Image size 2352x1568: 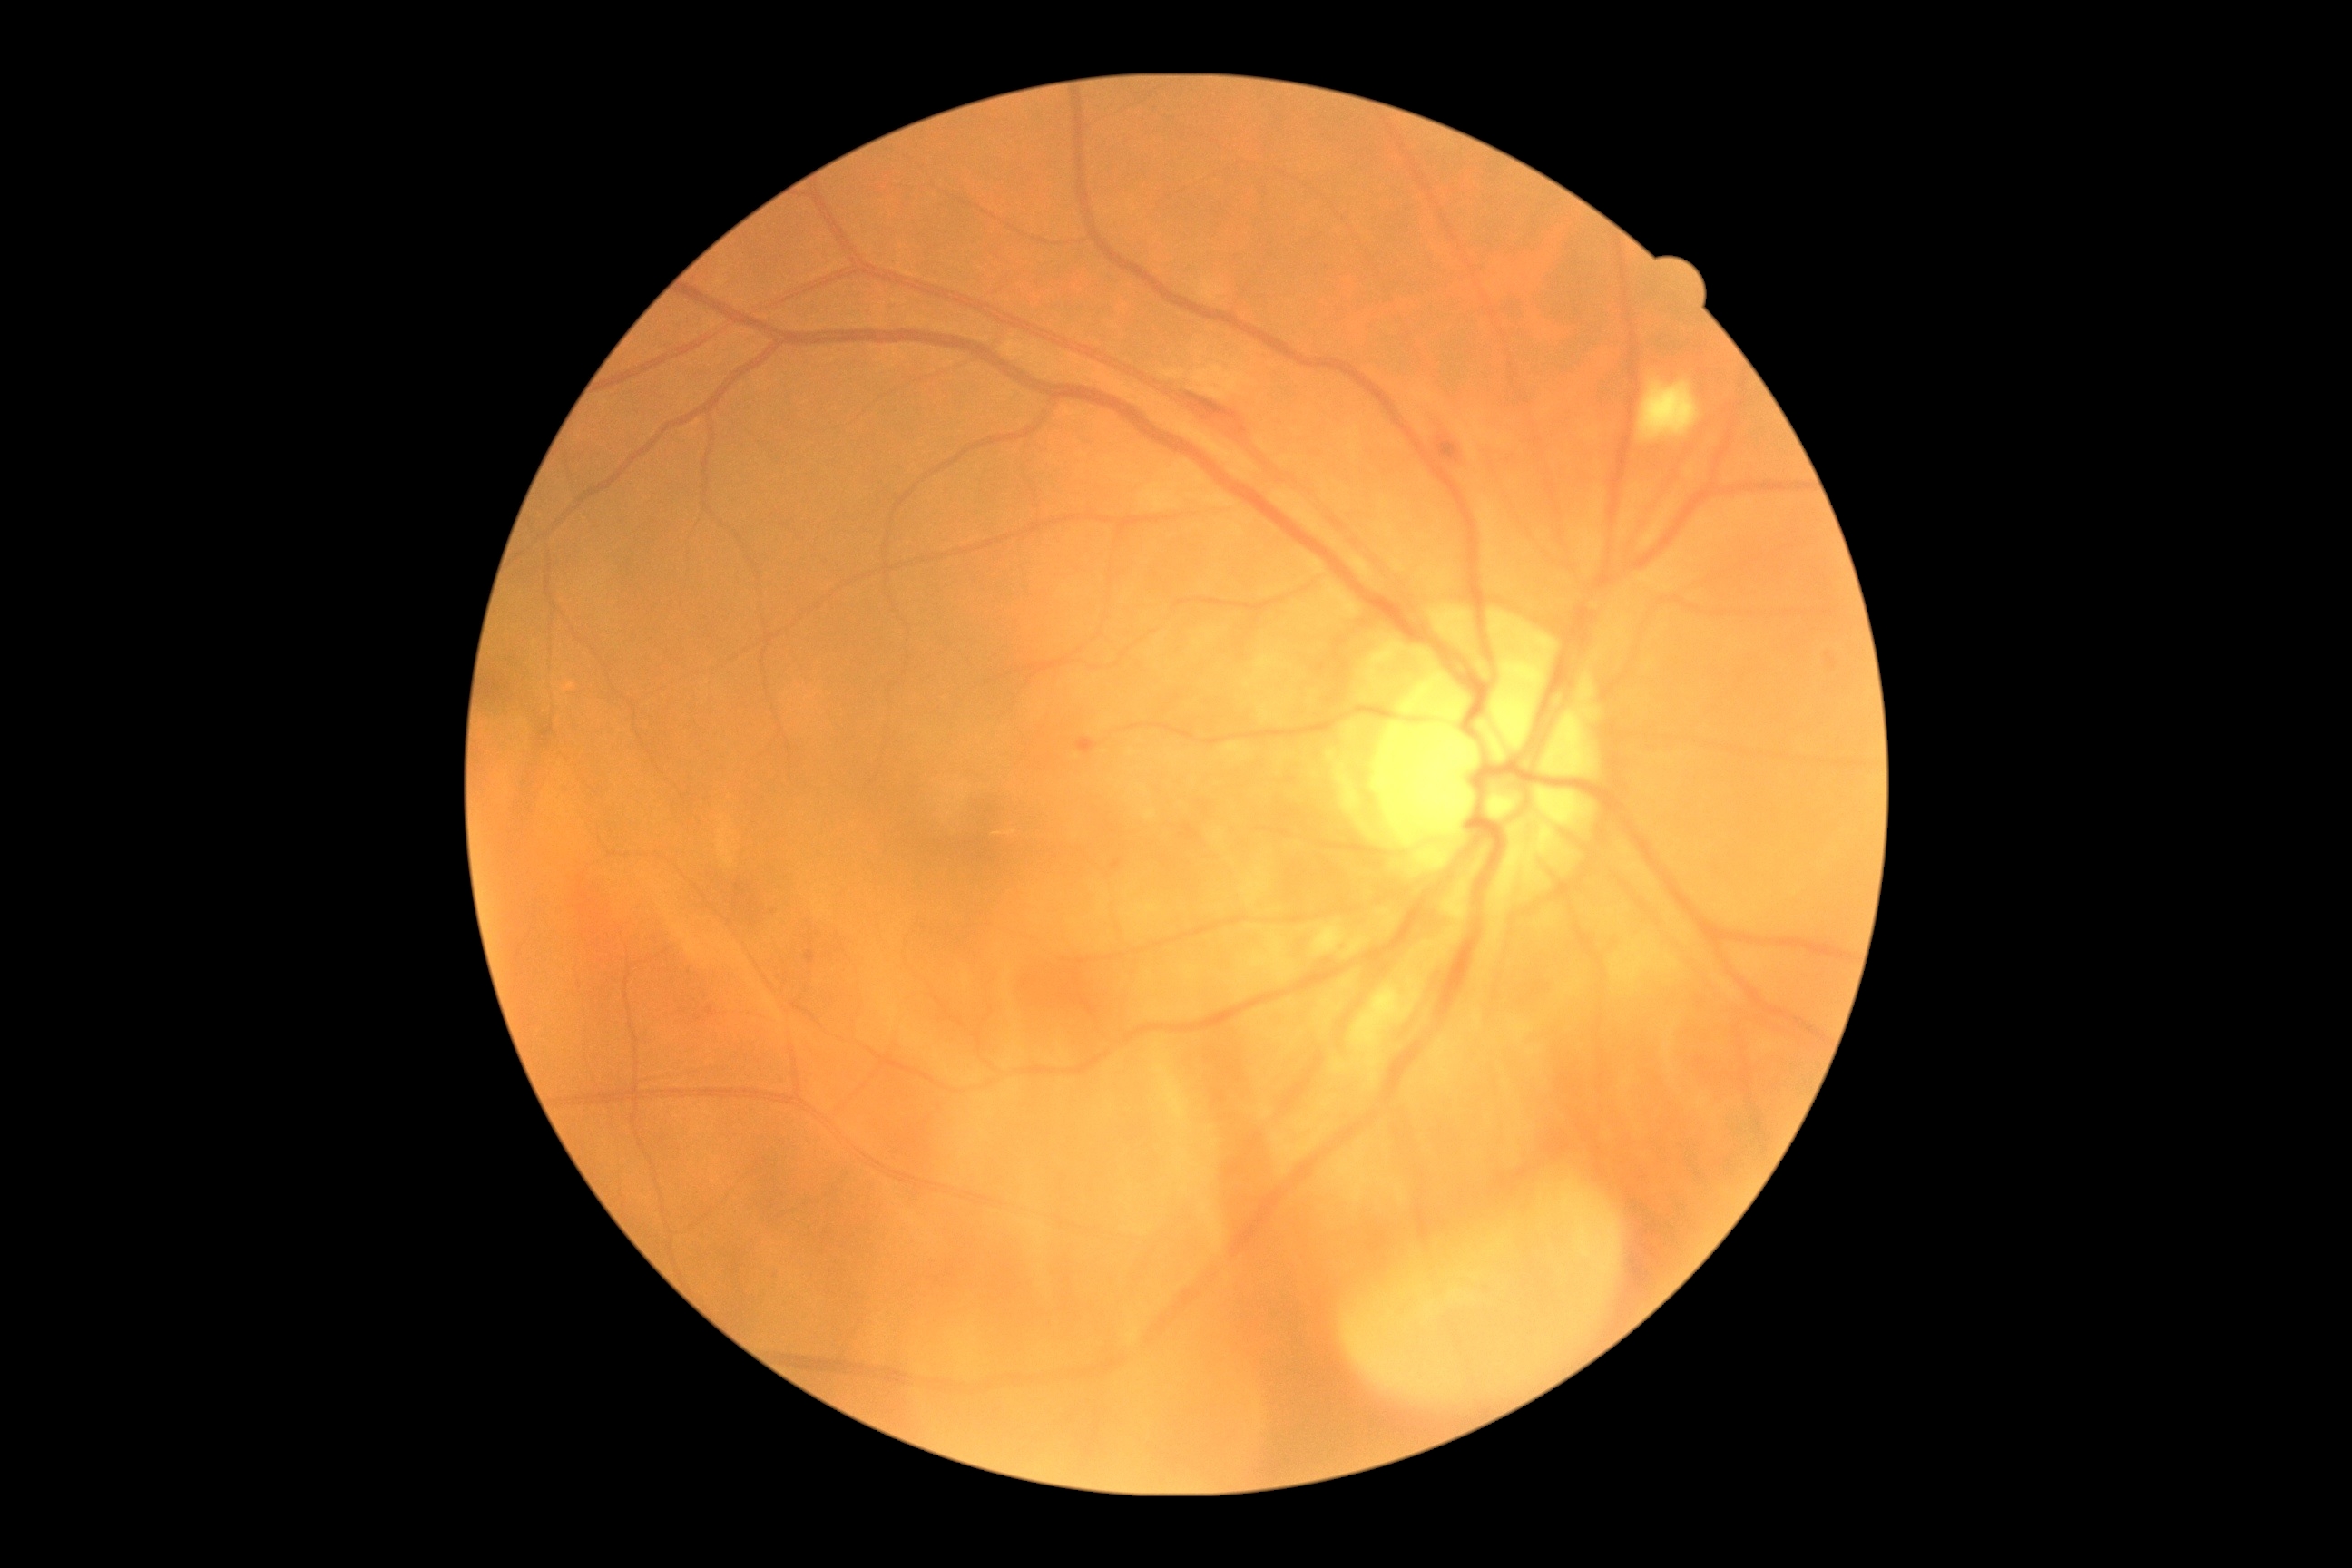 DR class: non-proliferative diabetic retinopathy.
Diabetic retinopathy grade is 2.